45° field of view; image size 2346x1568: 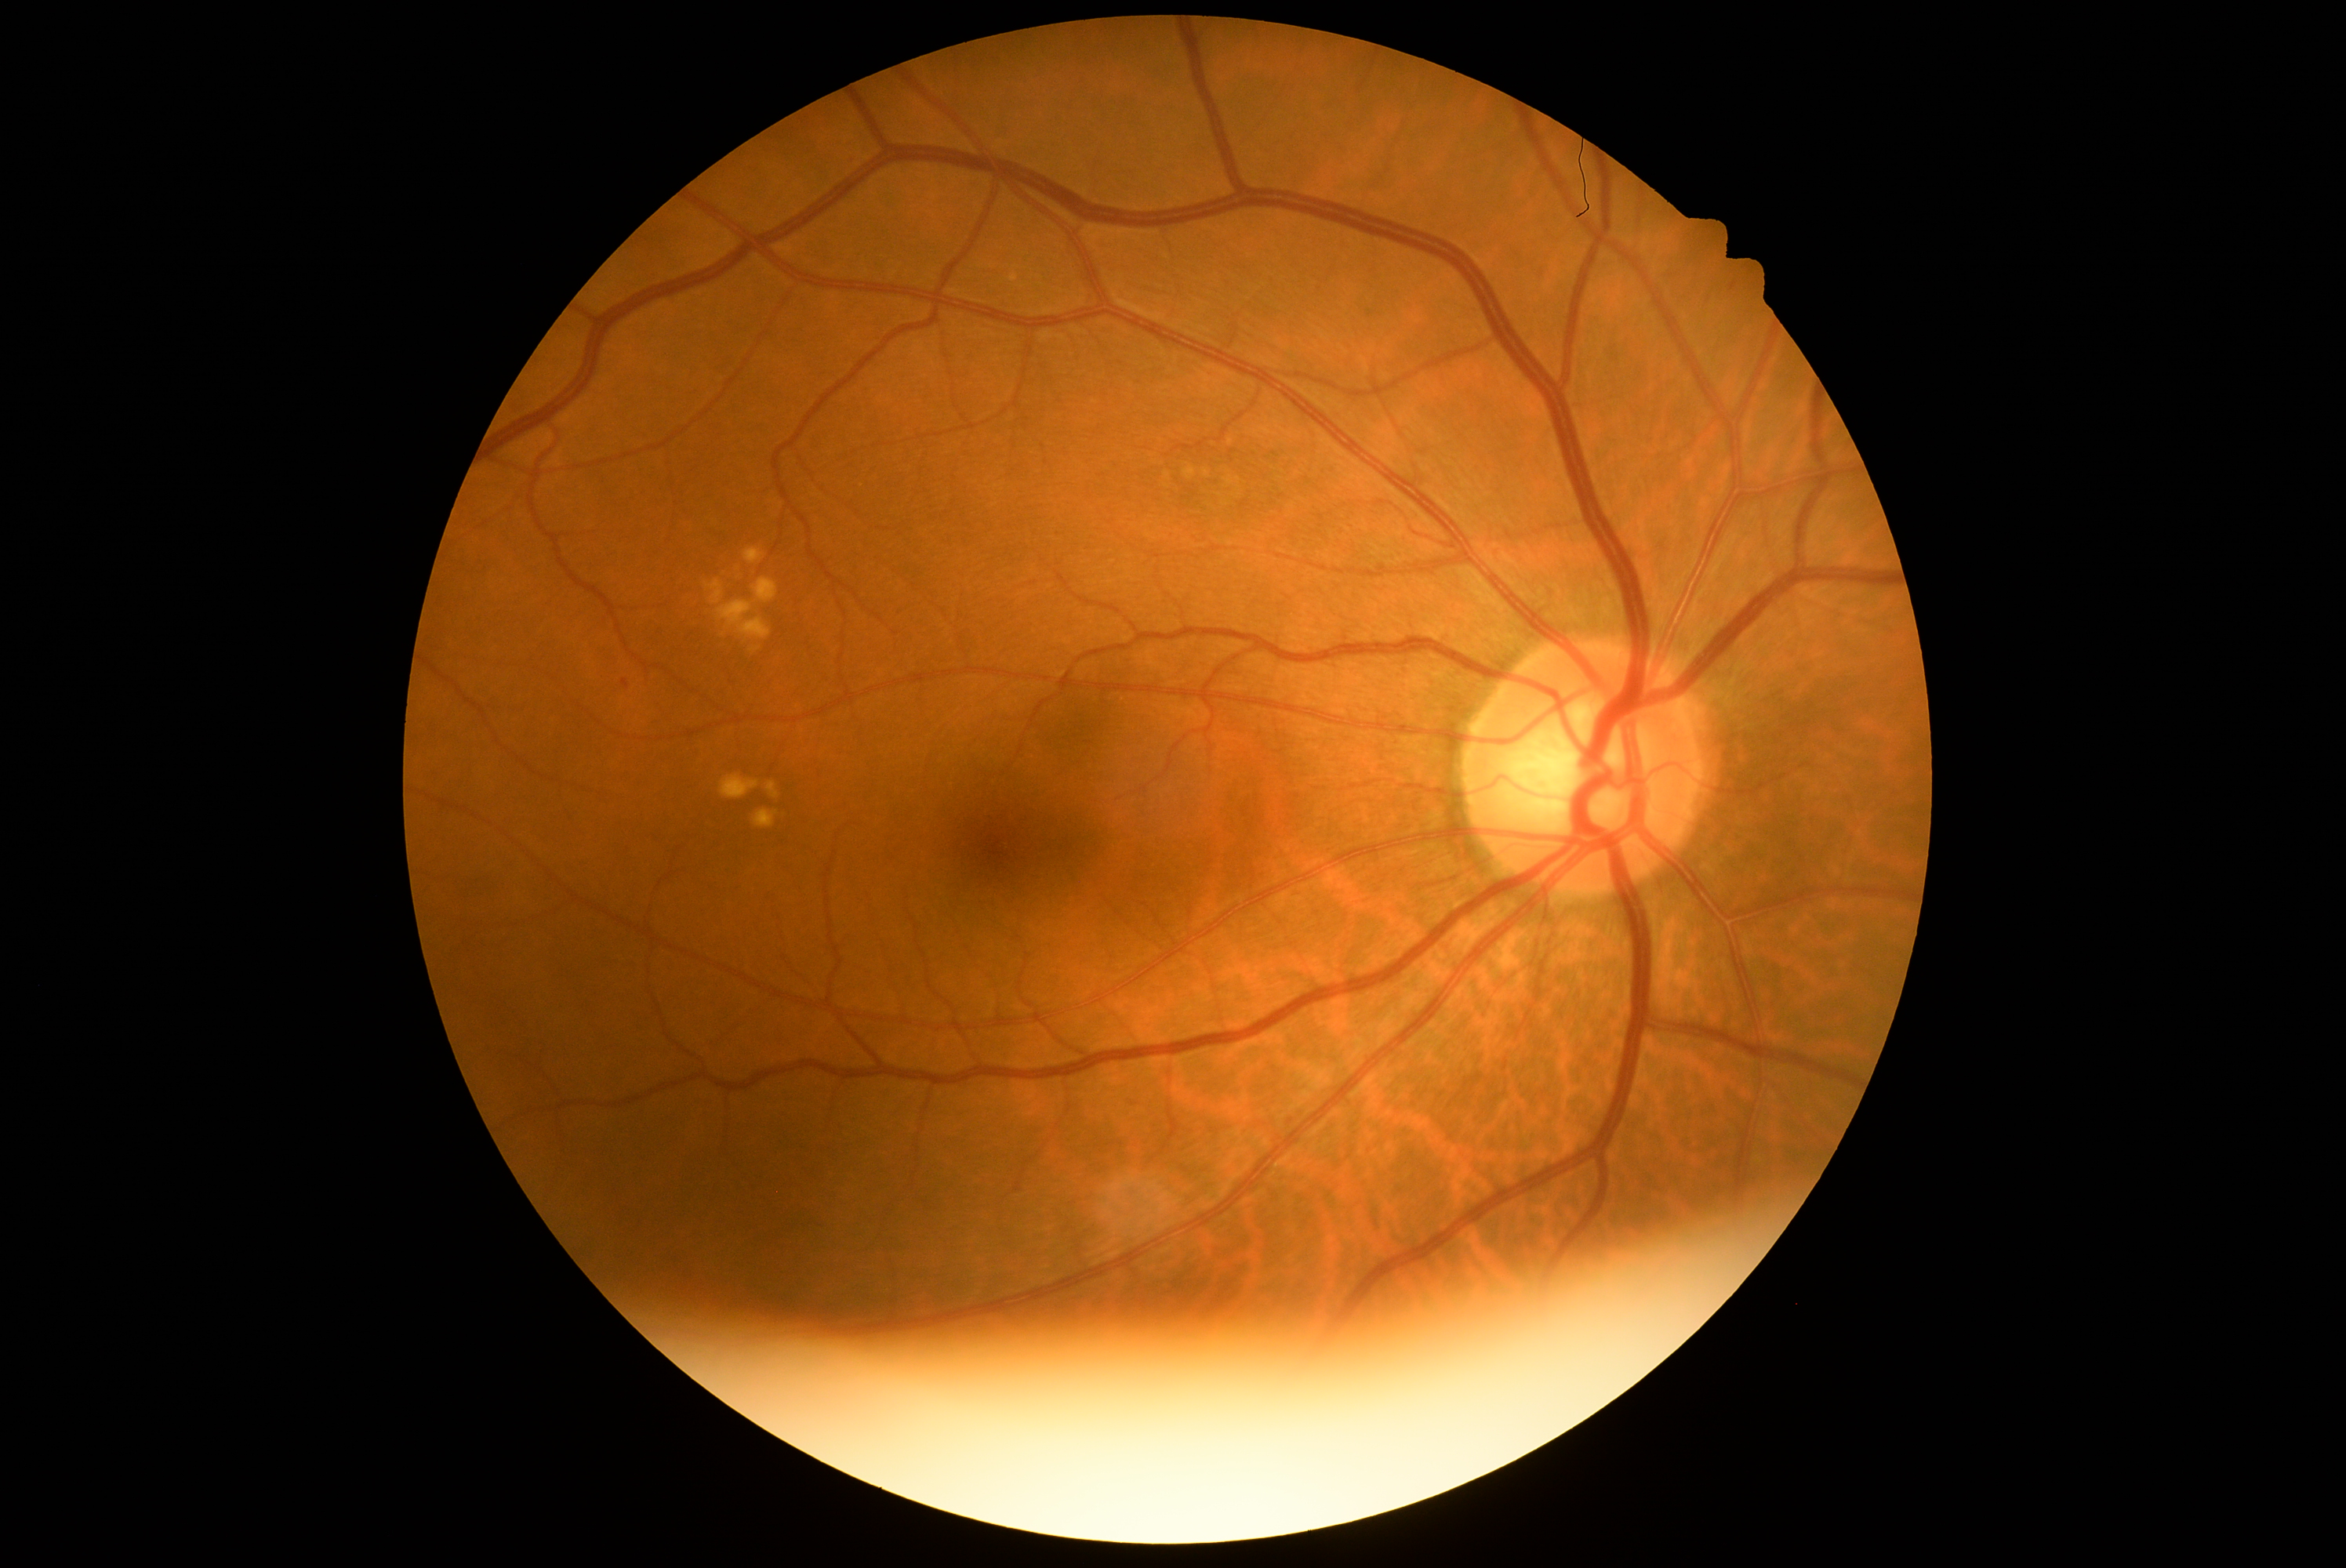
DR stage is grade 1 (mild NPDR).